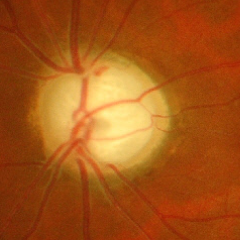 Showing severe glaucomatous damage.